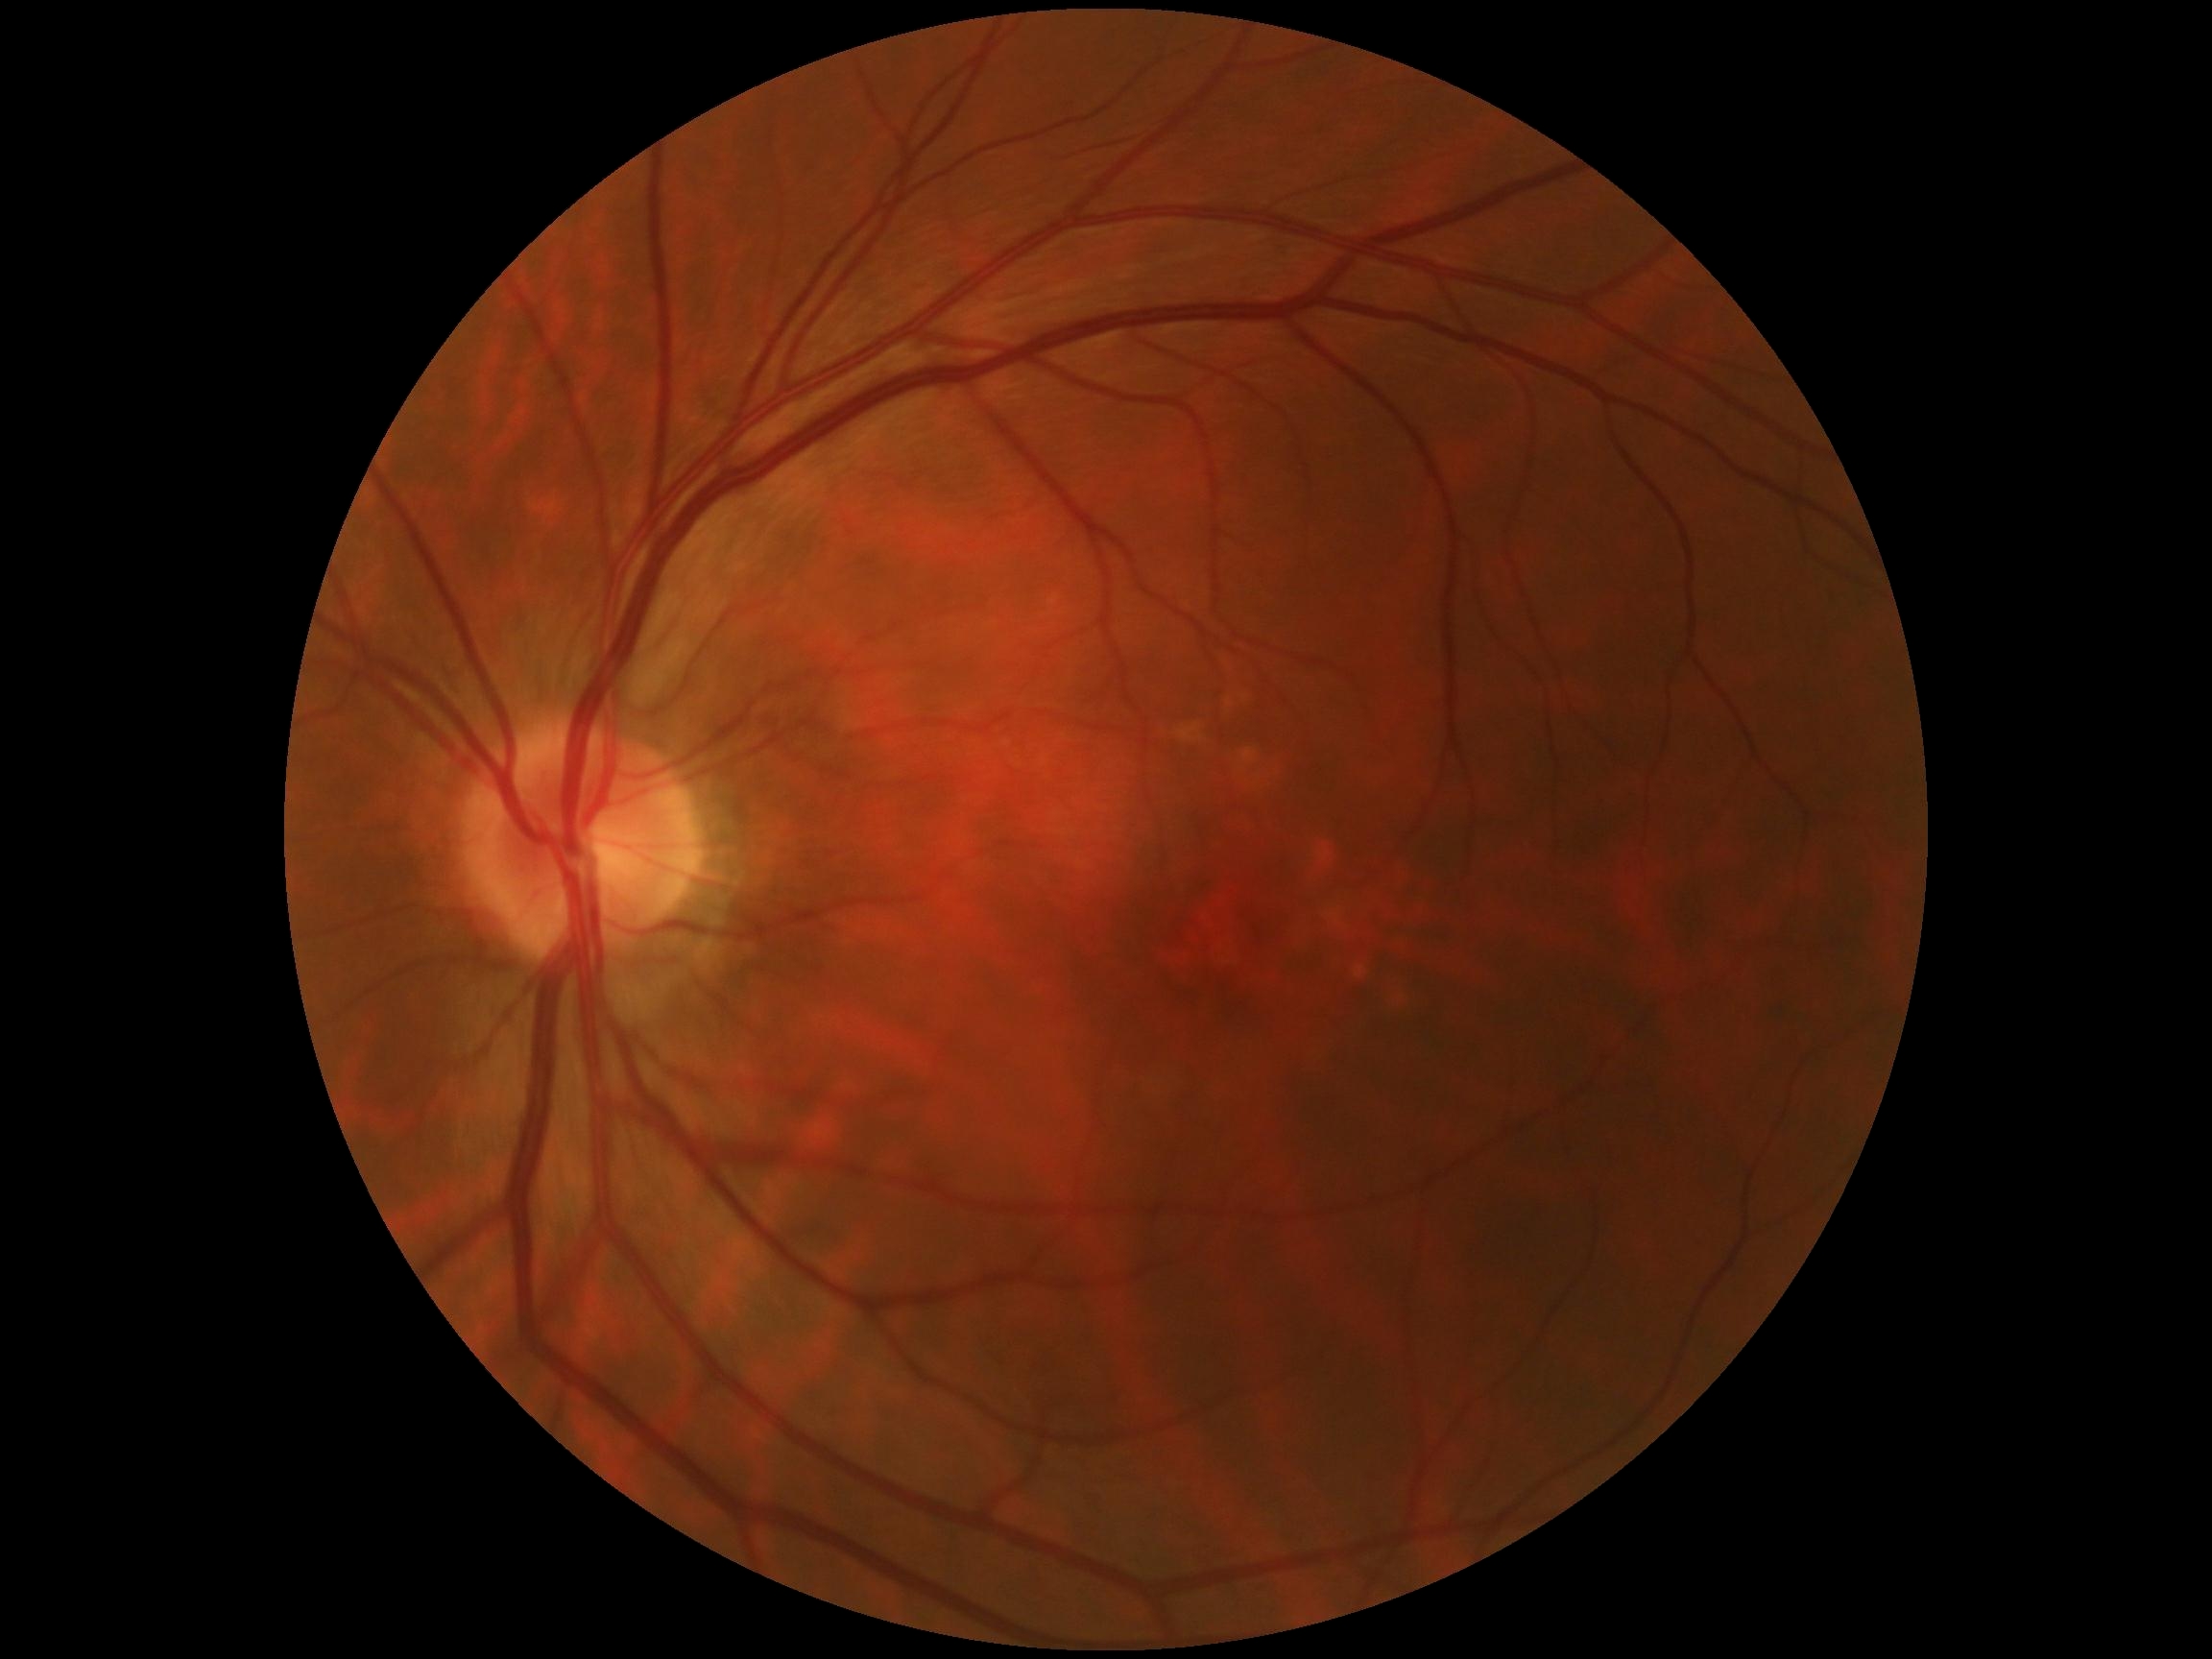

Diabetic retinopathy is 0/4.